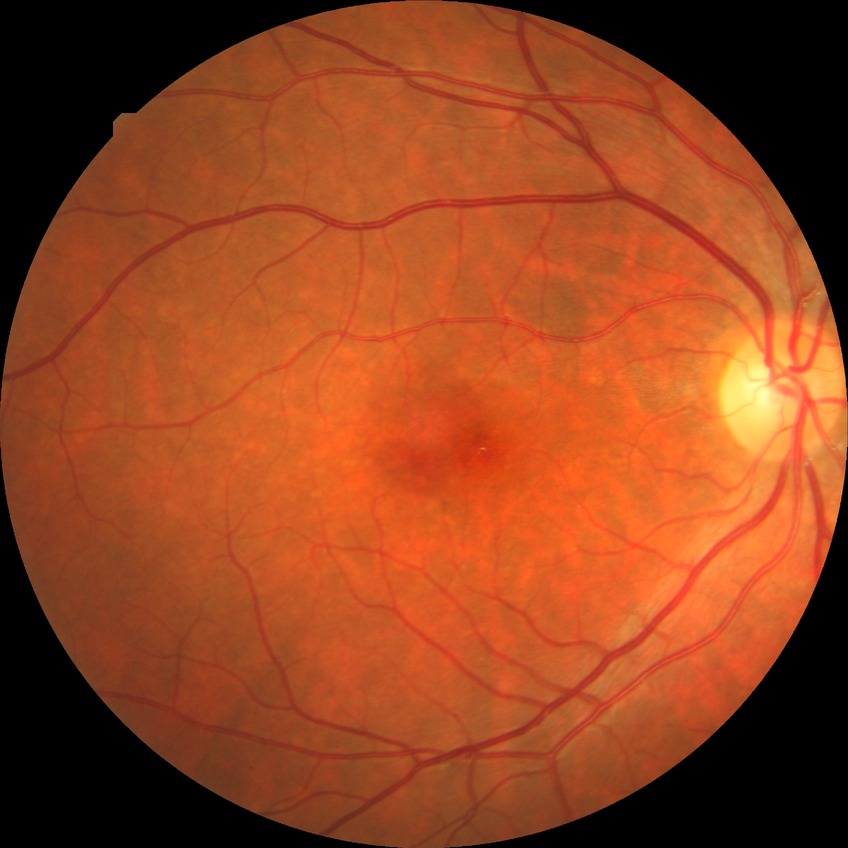 modified Davis grading: no diabetic retinopathy.